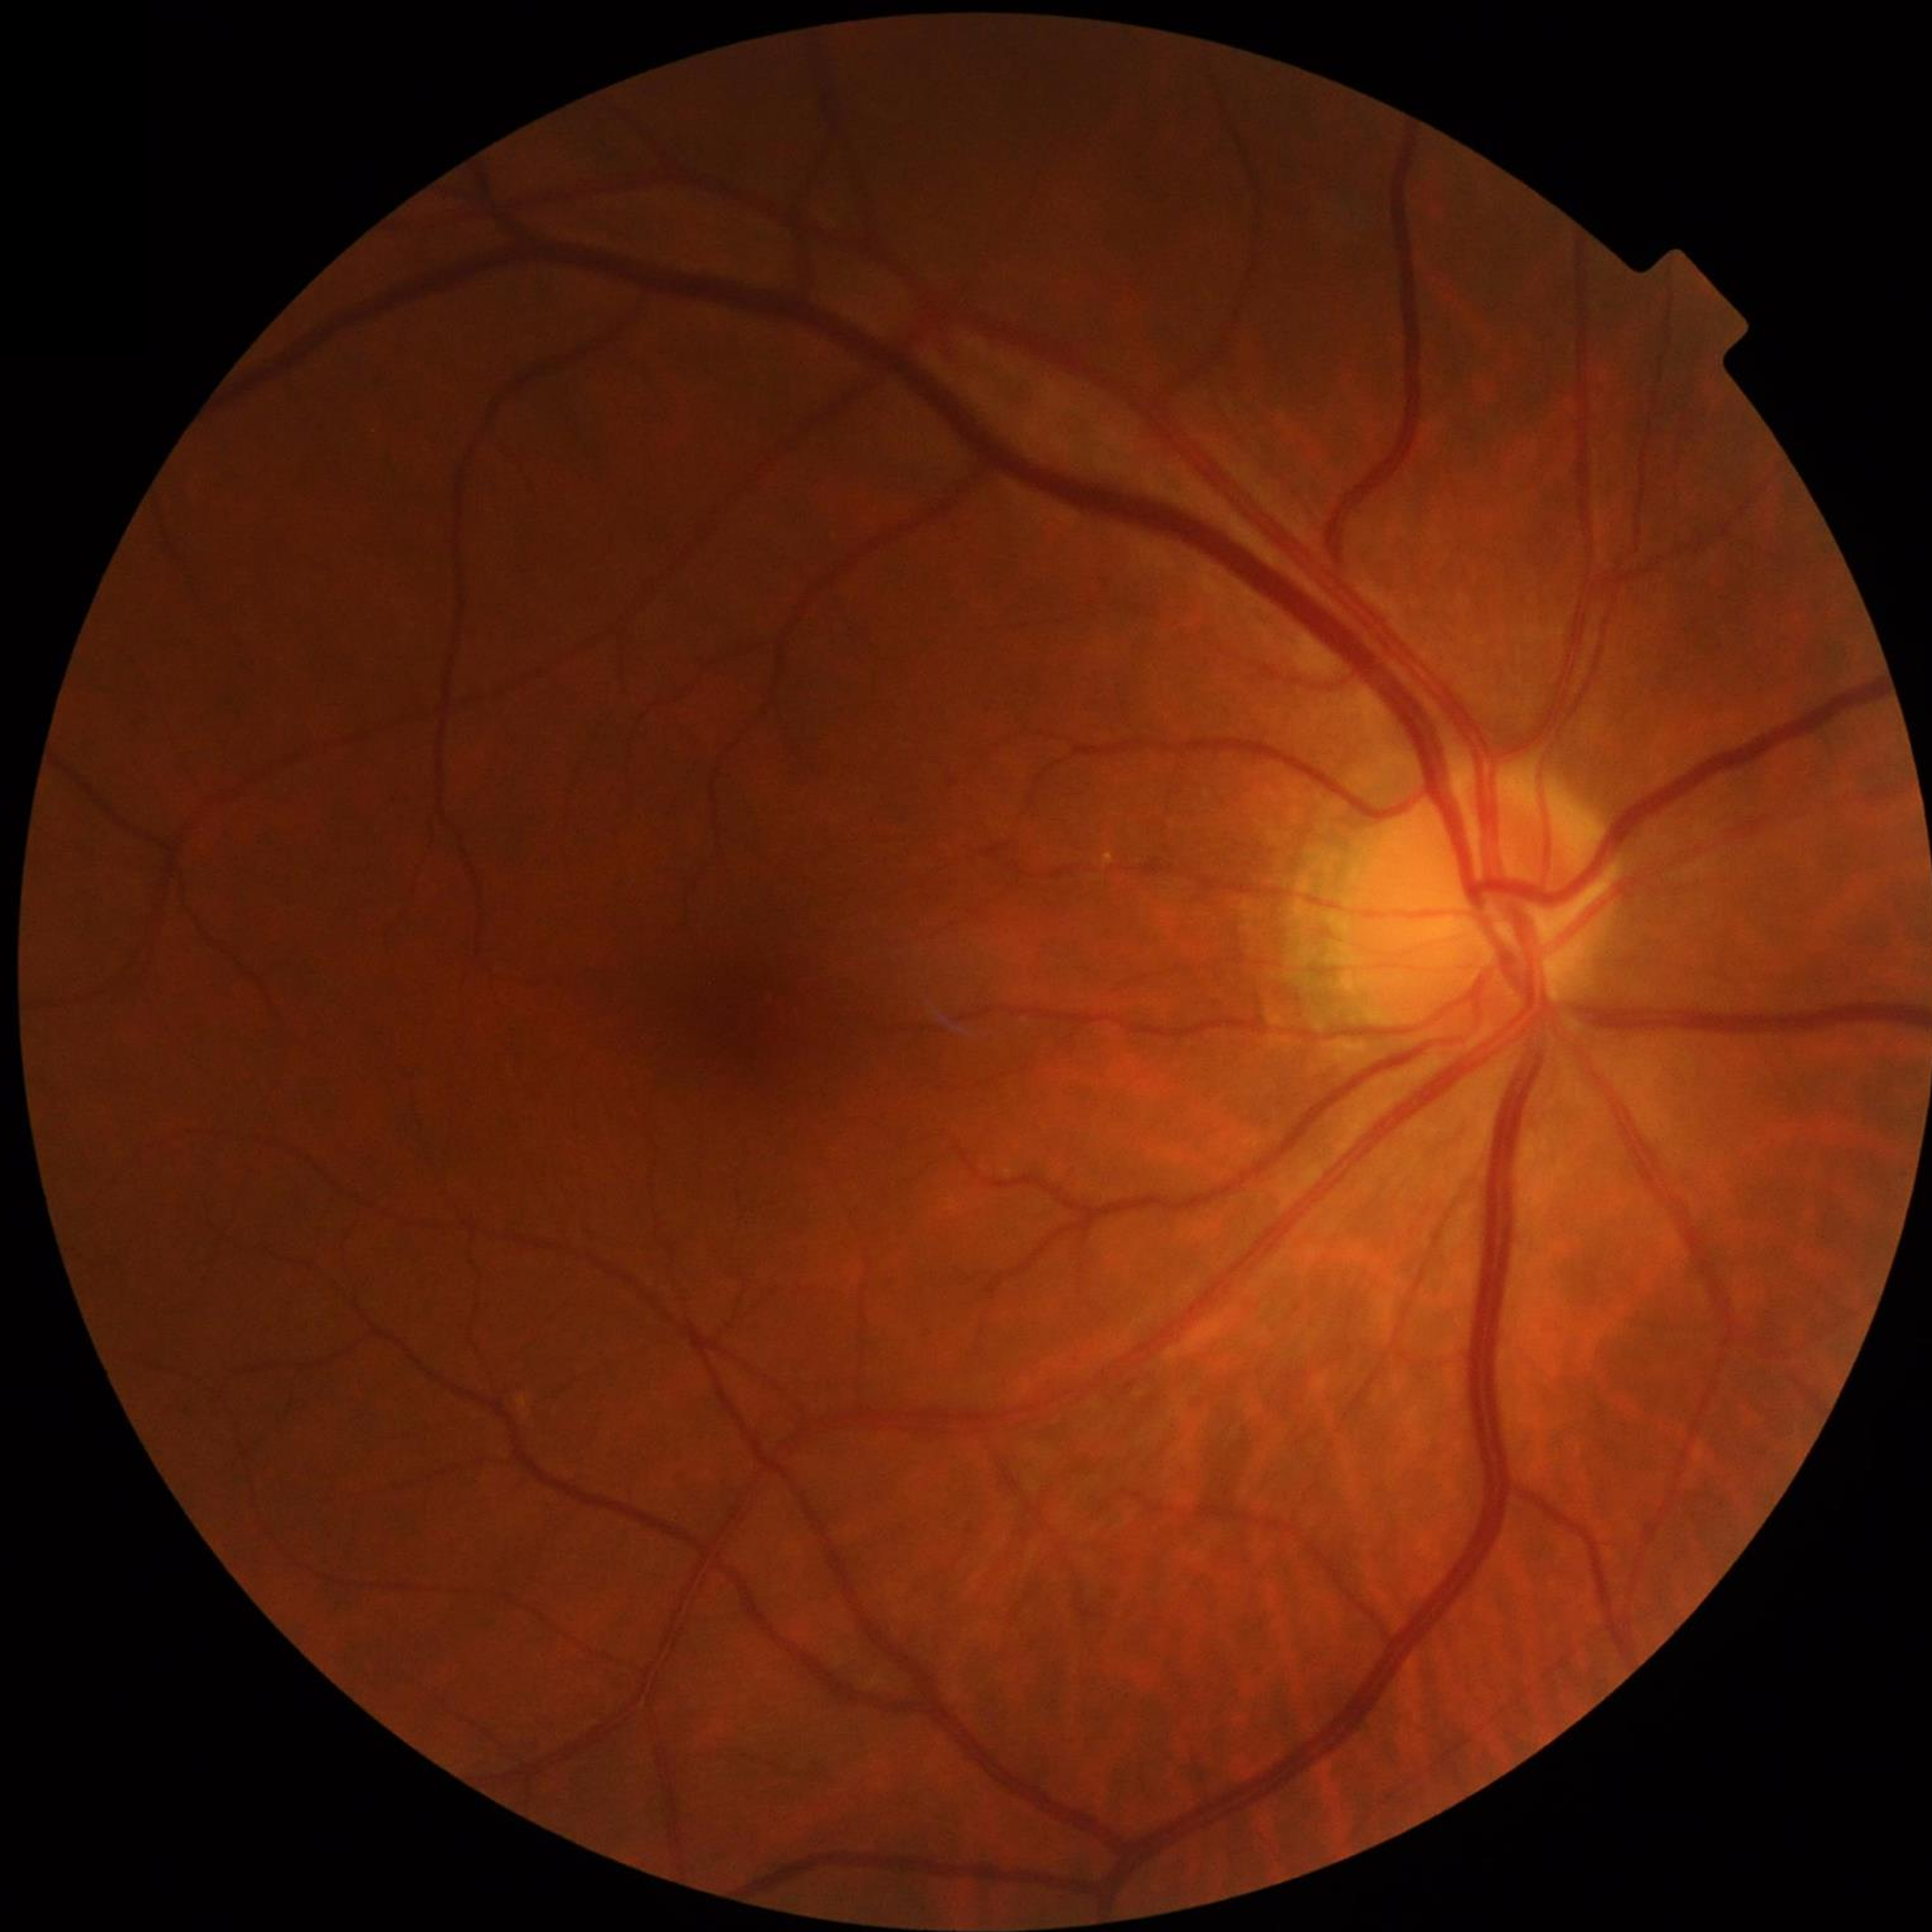 Diagnosis: no AMD, DR, or glaucoma